Camera: Remidio smartphone fundus camera; image size 1659x2212 — 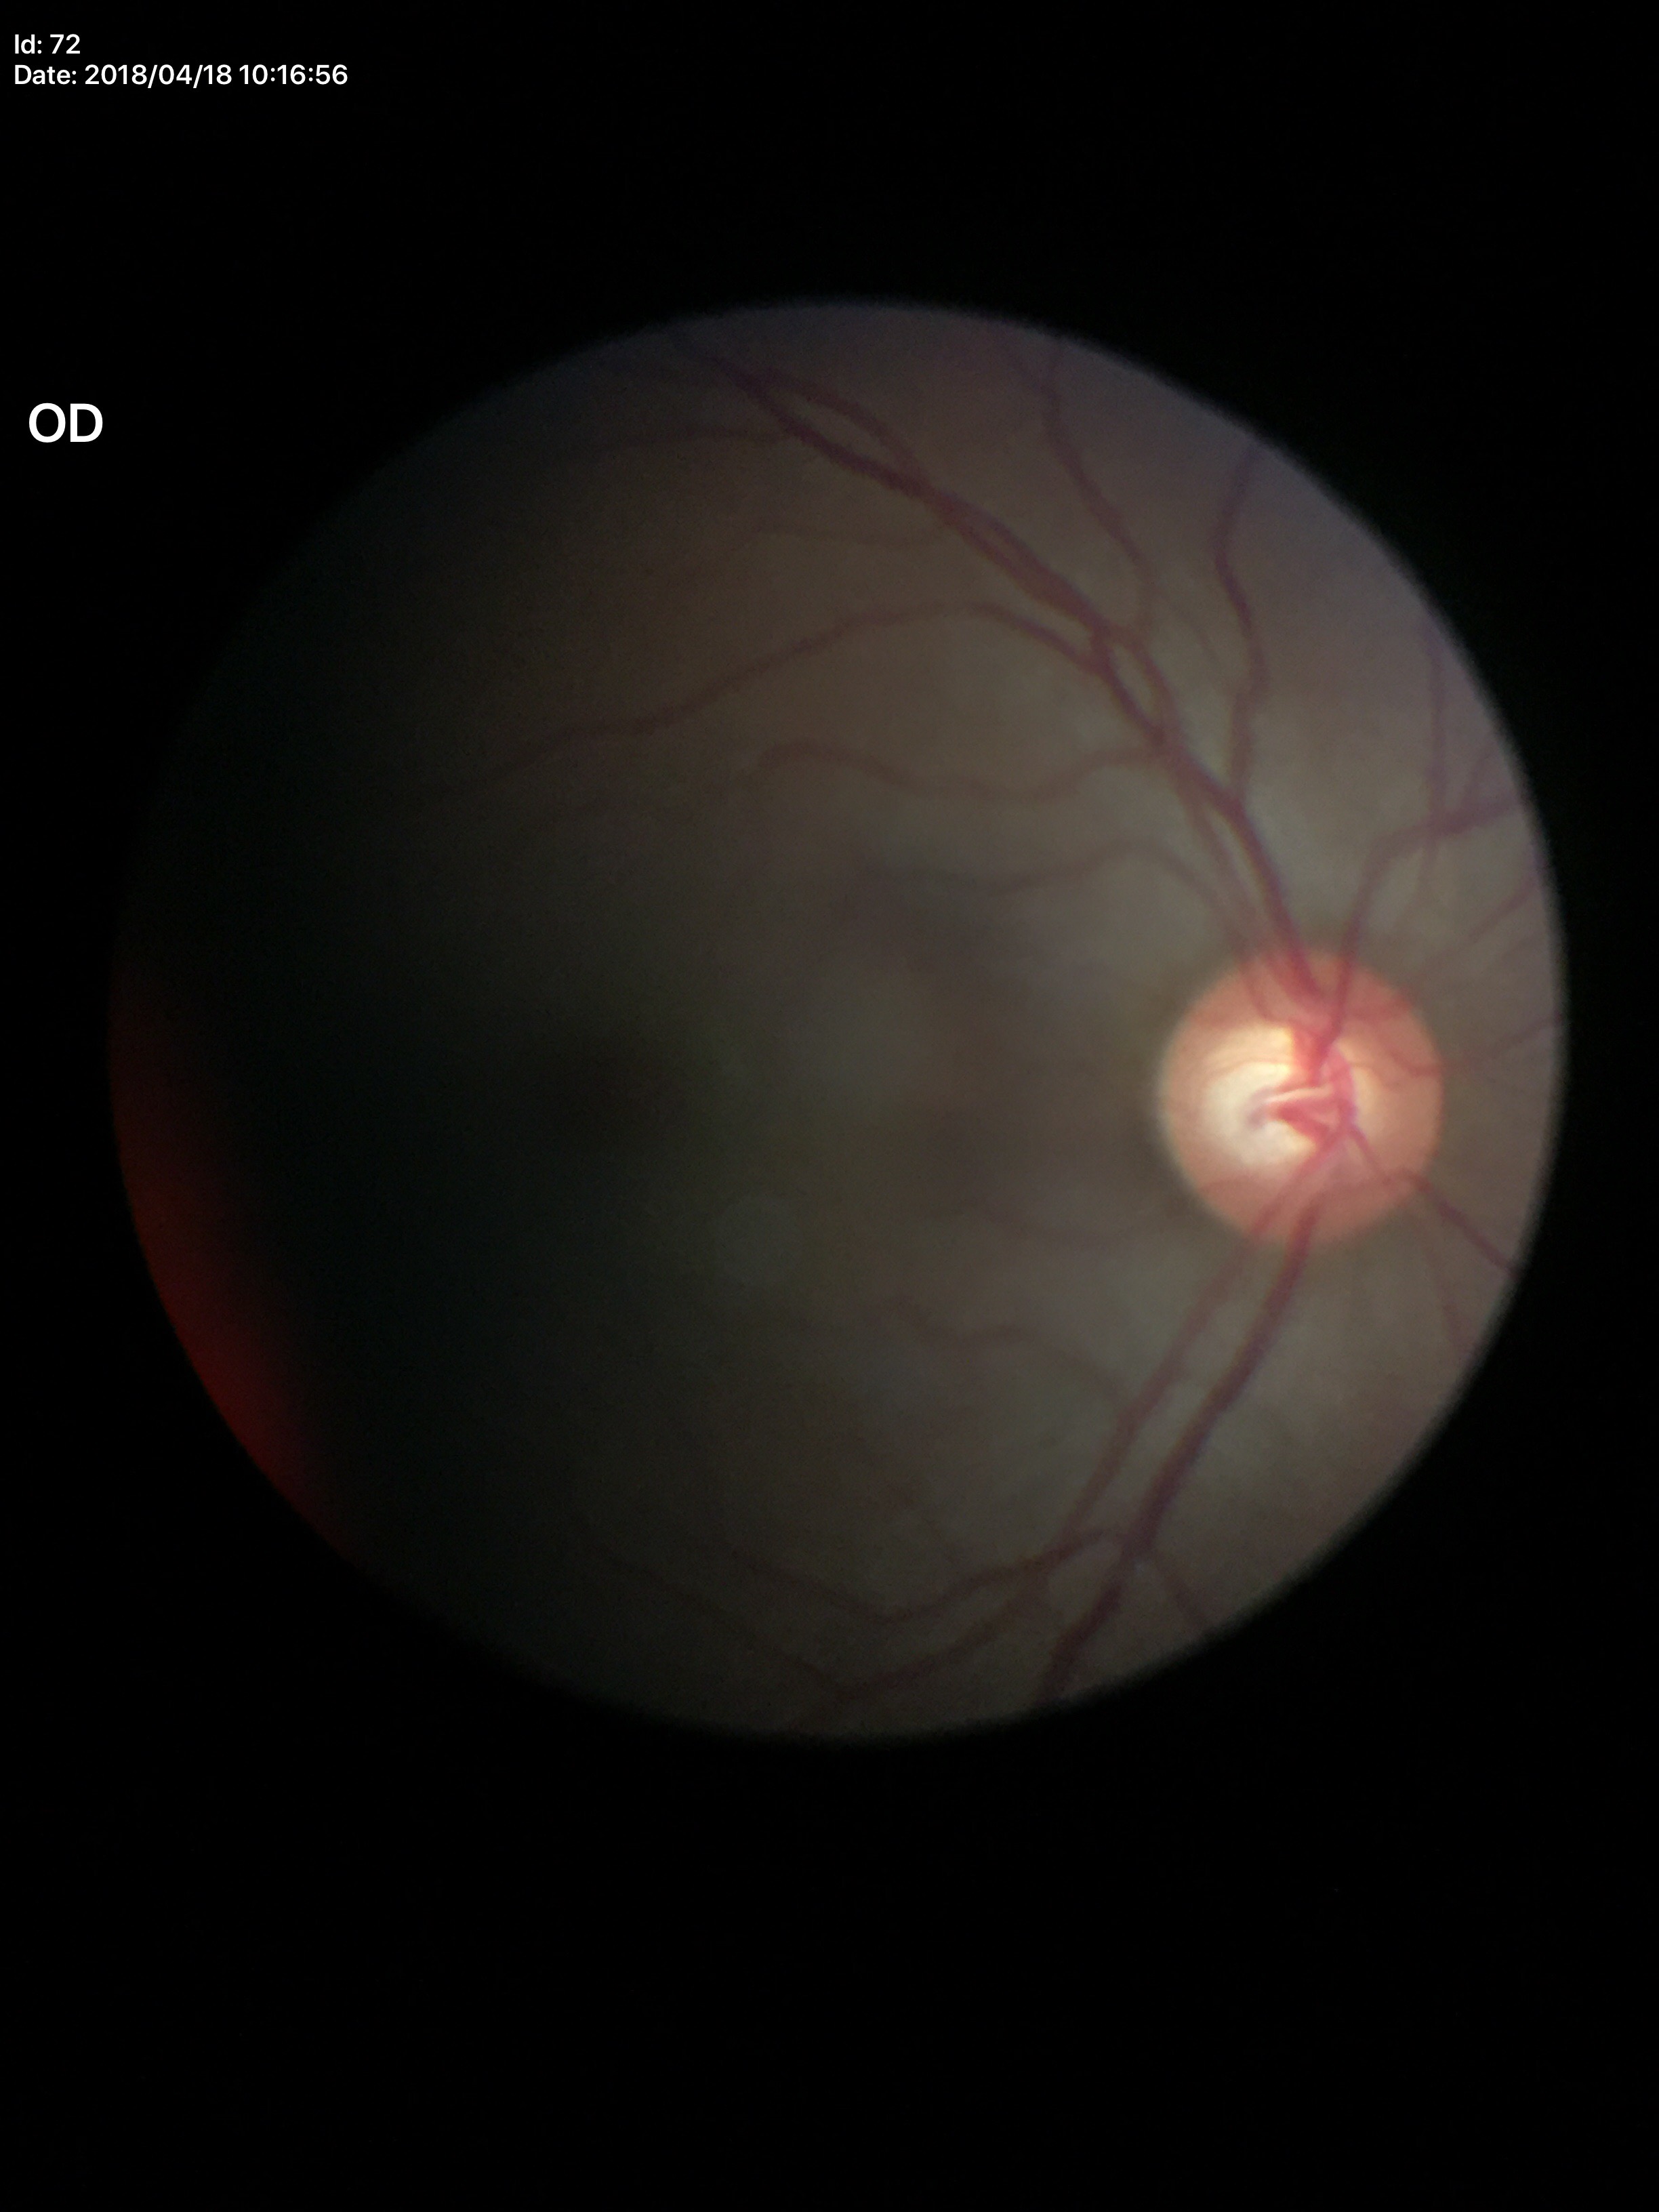
– Glaucoma evaluation · suspicious
– horizontal cup-disc ratio (HCDR) · 0.66
– vertical cup-disc ratio (VCDR) · 0.60